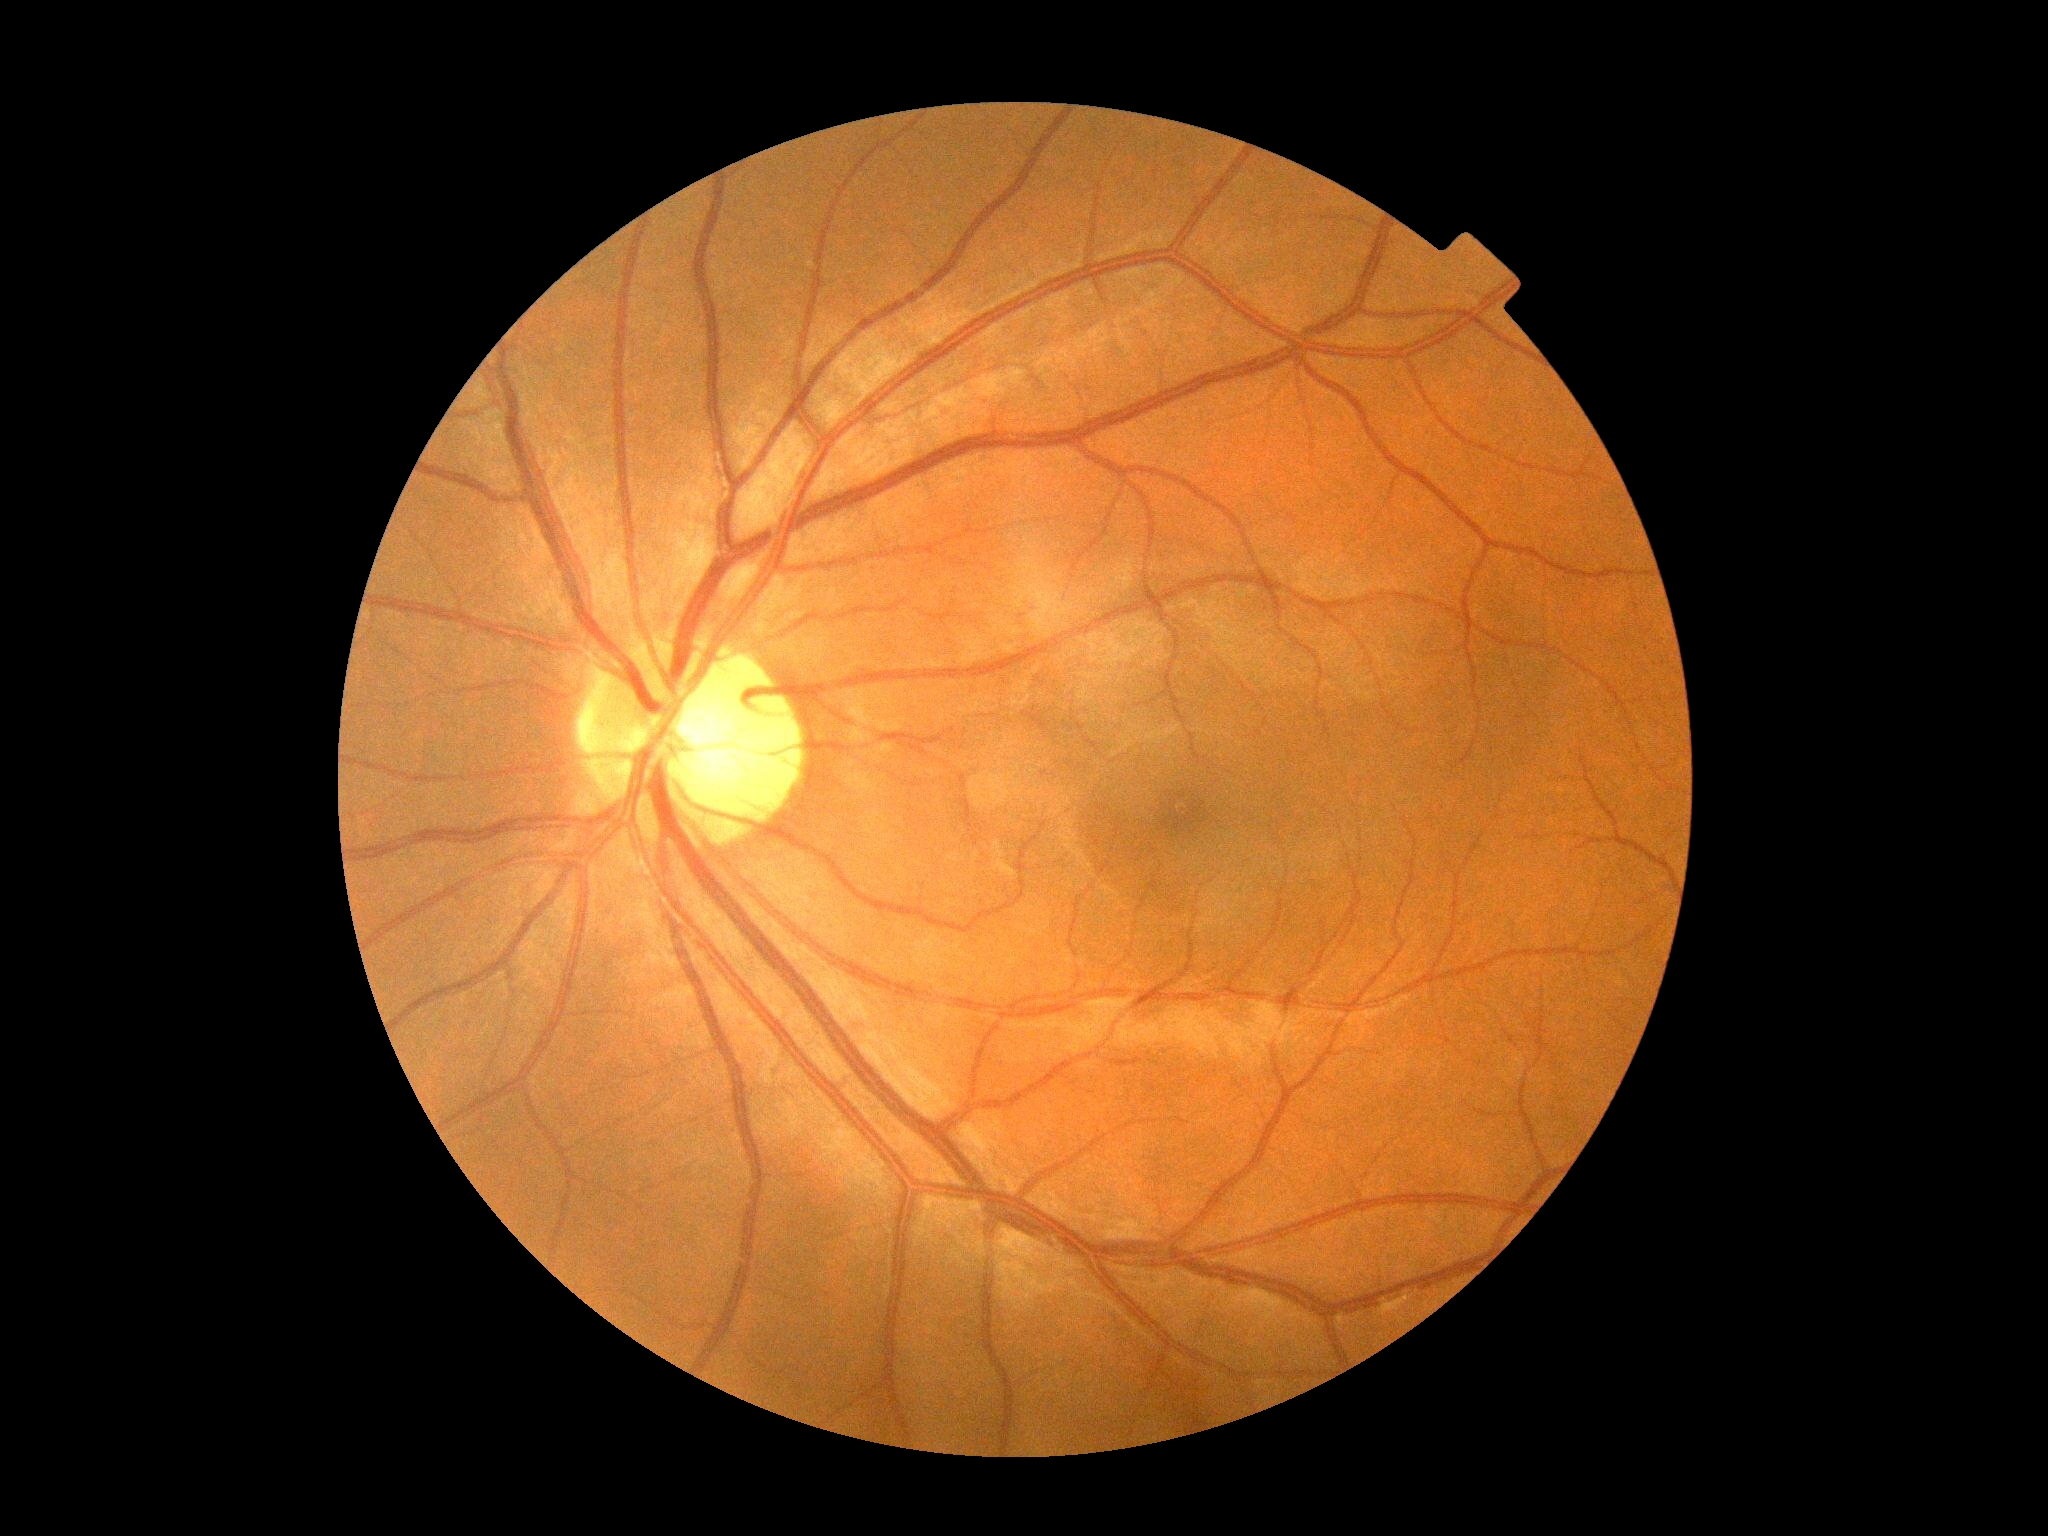

No DR findings.
Diabetic retinopathy (DR) is grade 0 (no apparent retinopathy).